848 x 848 pixels — 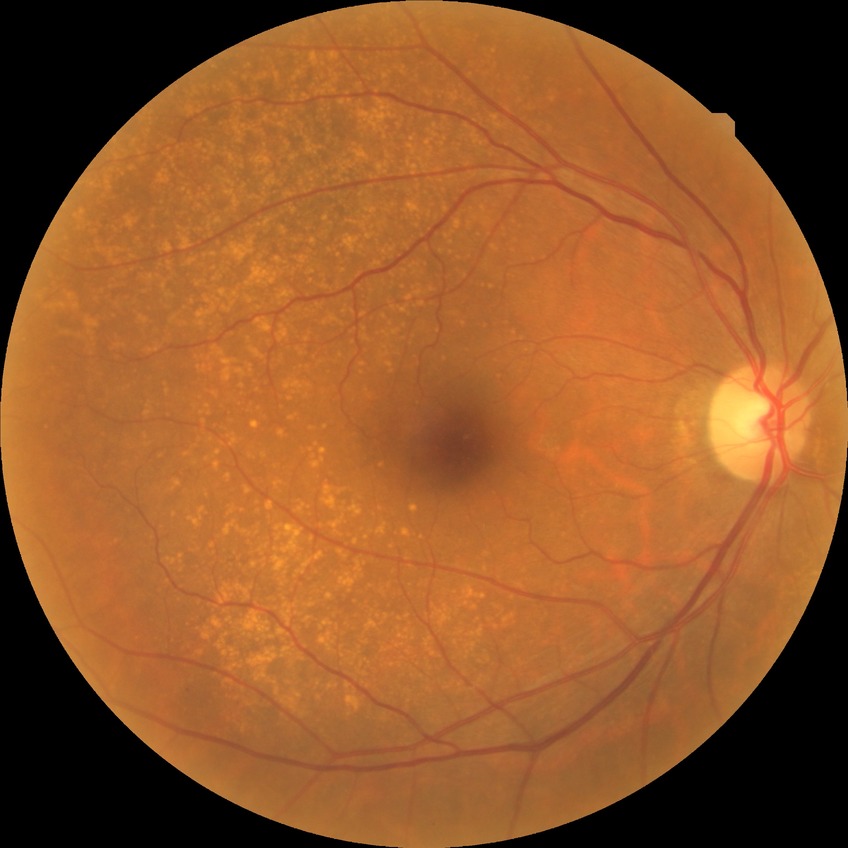

Diabetic retinopathy (DR) is NDR (no diabetic retinopathy).